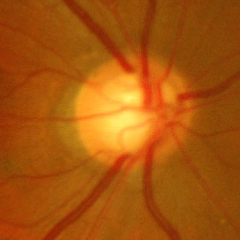 Impression = advanced glaucomatous optic neuropathy.